45° field of view, fundus photo, image size 2352x1568: 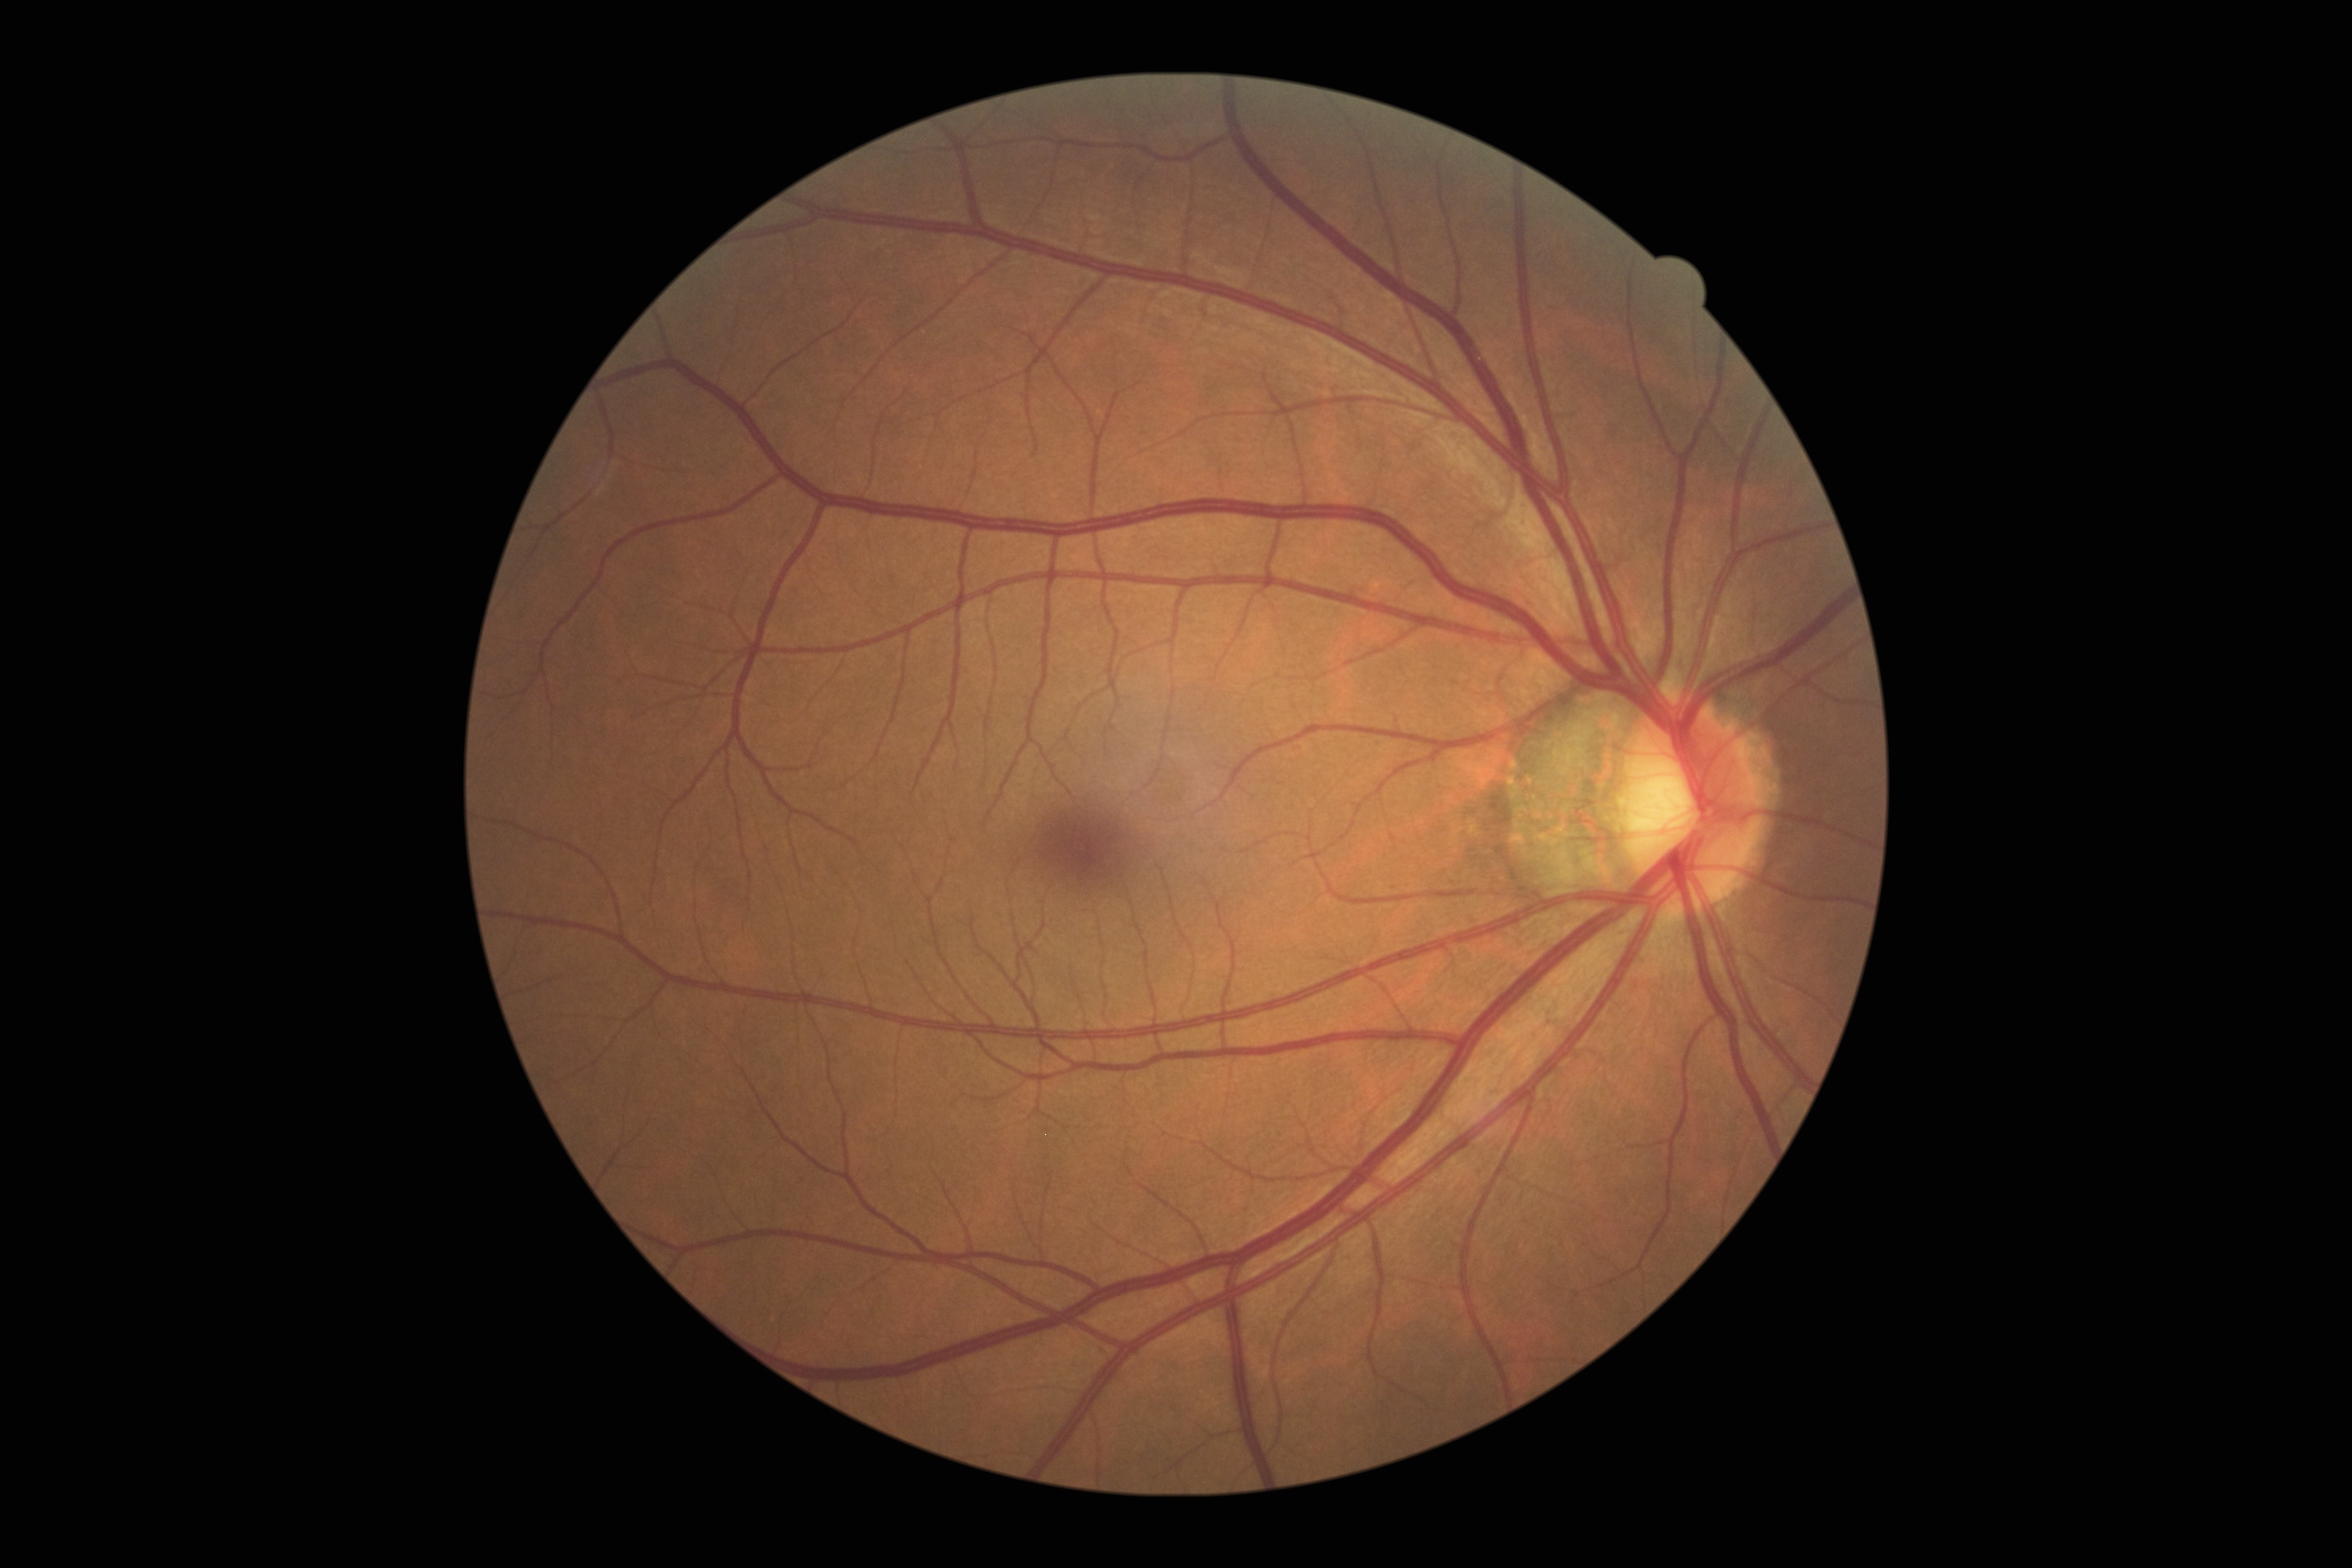 Findings:
• DR impression — no DR findings
• diabetic retinopathy grade — 0